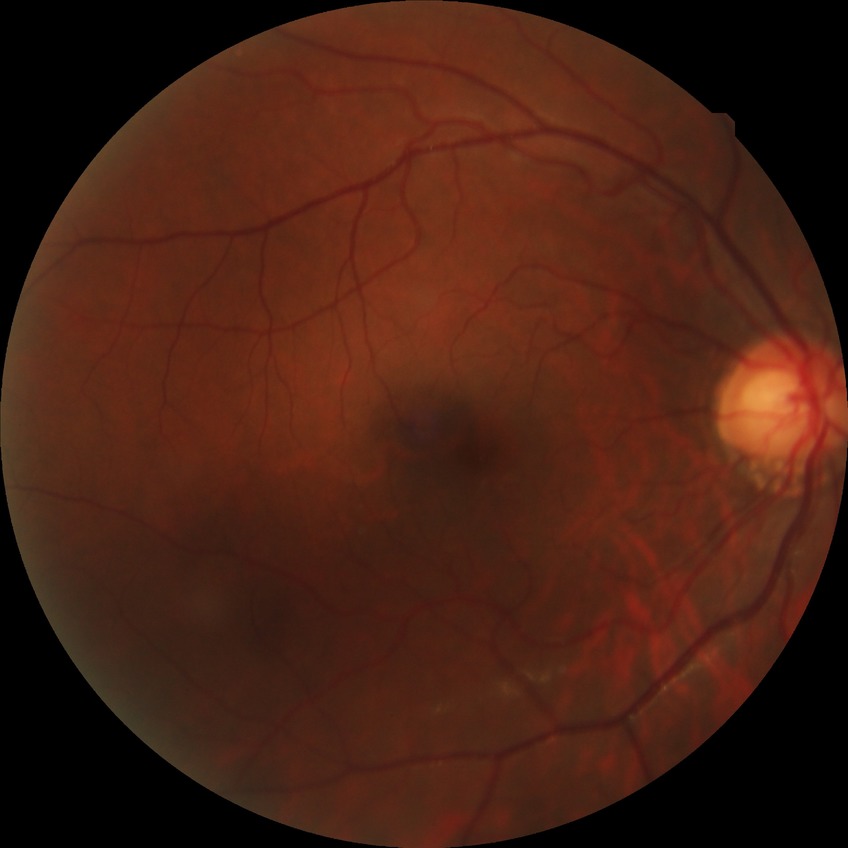

diabetic retinopathy (DR)=NDR (no diabetic retinopathy).